CFP. 1659x2212. Camera: Remidio FOP fundus camera.
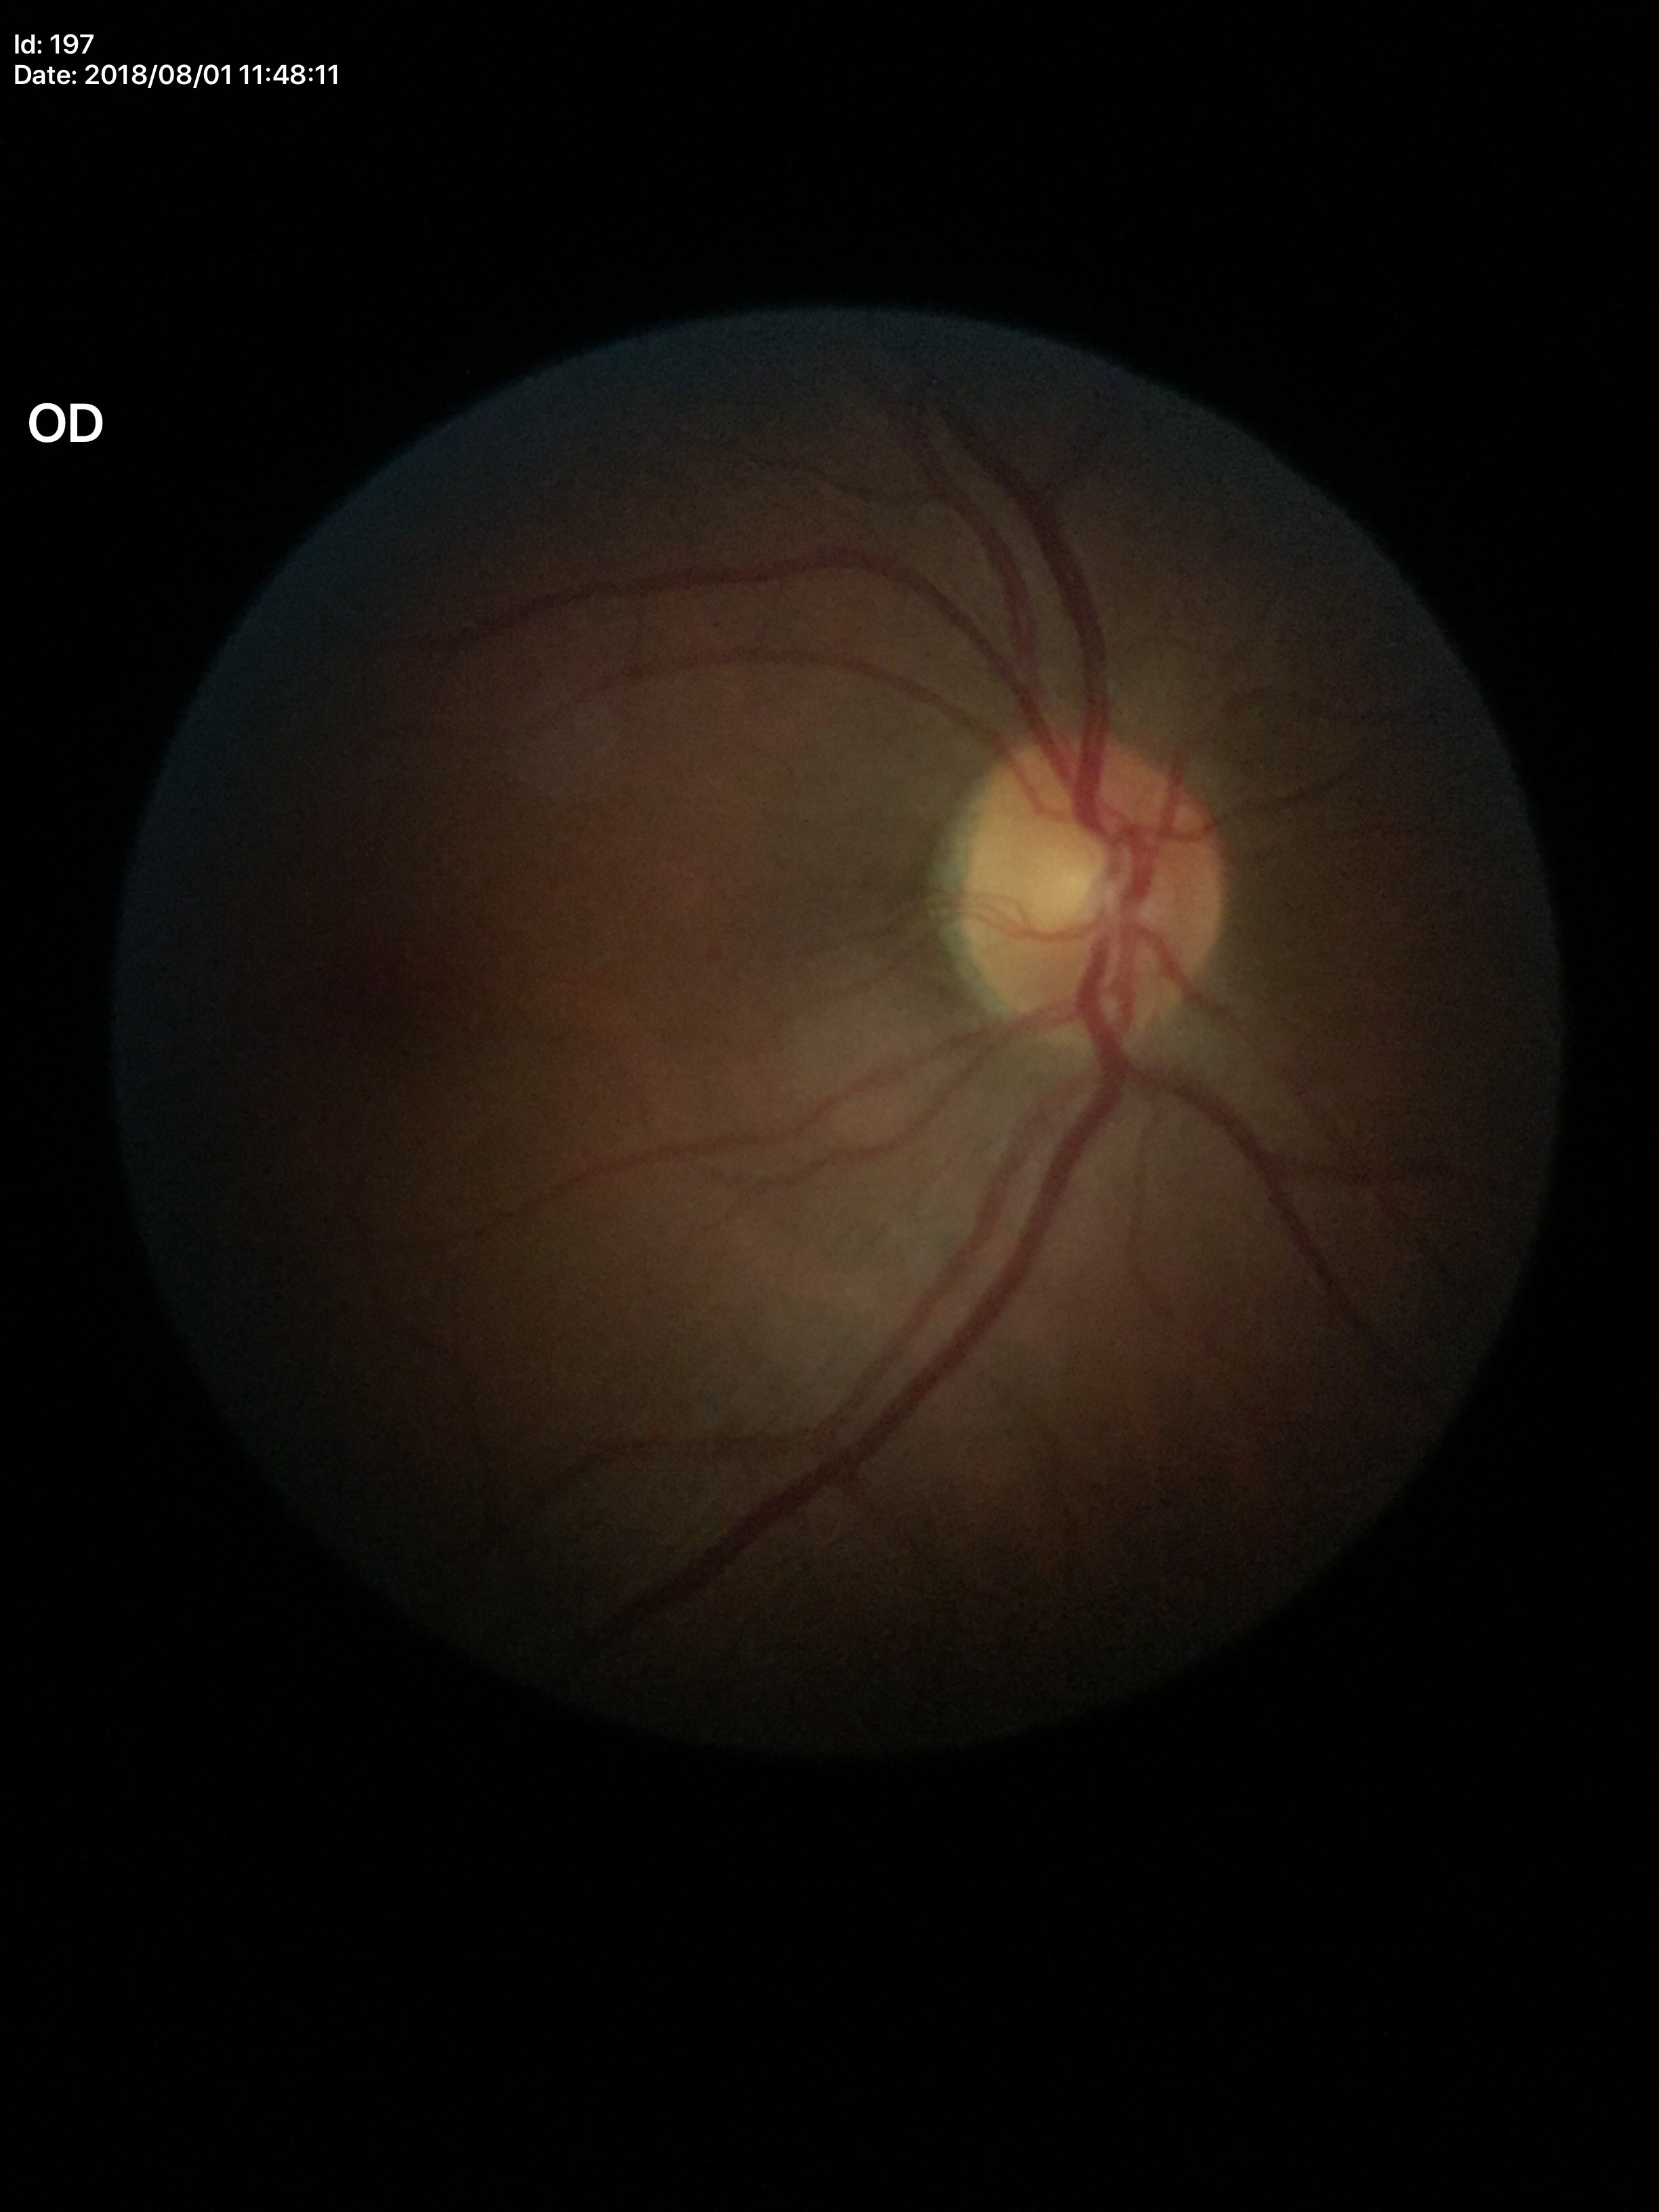 Glaucoma evaluation: no suspicious findings | VCDR: 0.47 | HCDR: 0.51 | ACDR: 0.24.